Non-mydriatic fundus camera · color fundus image
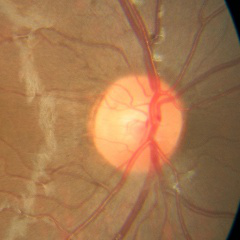

Glaucoma stage: no glaucomatous changes.